Color fundus image — 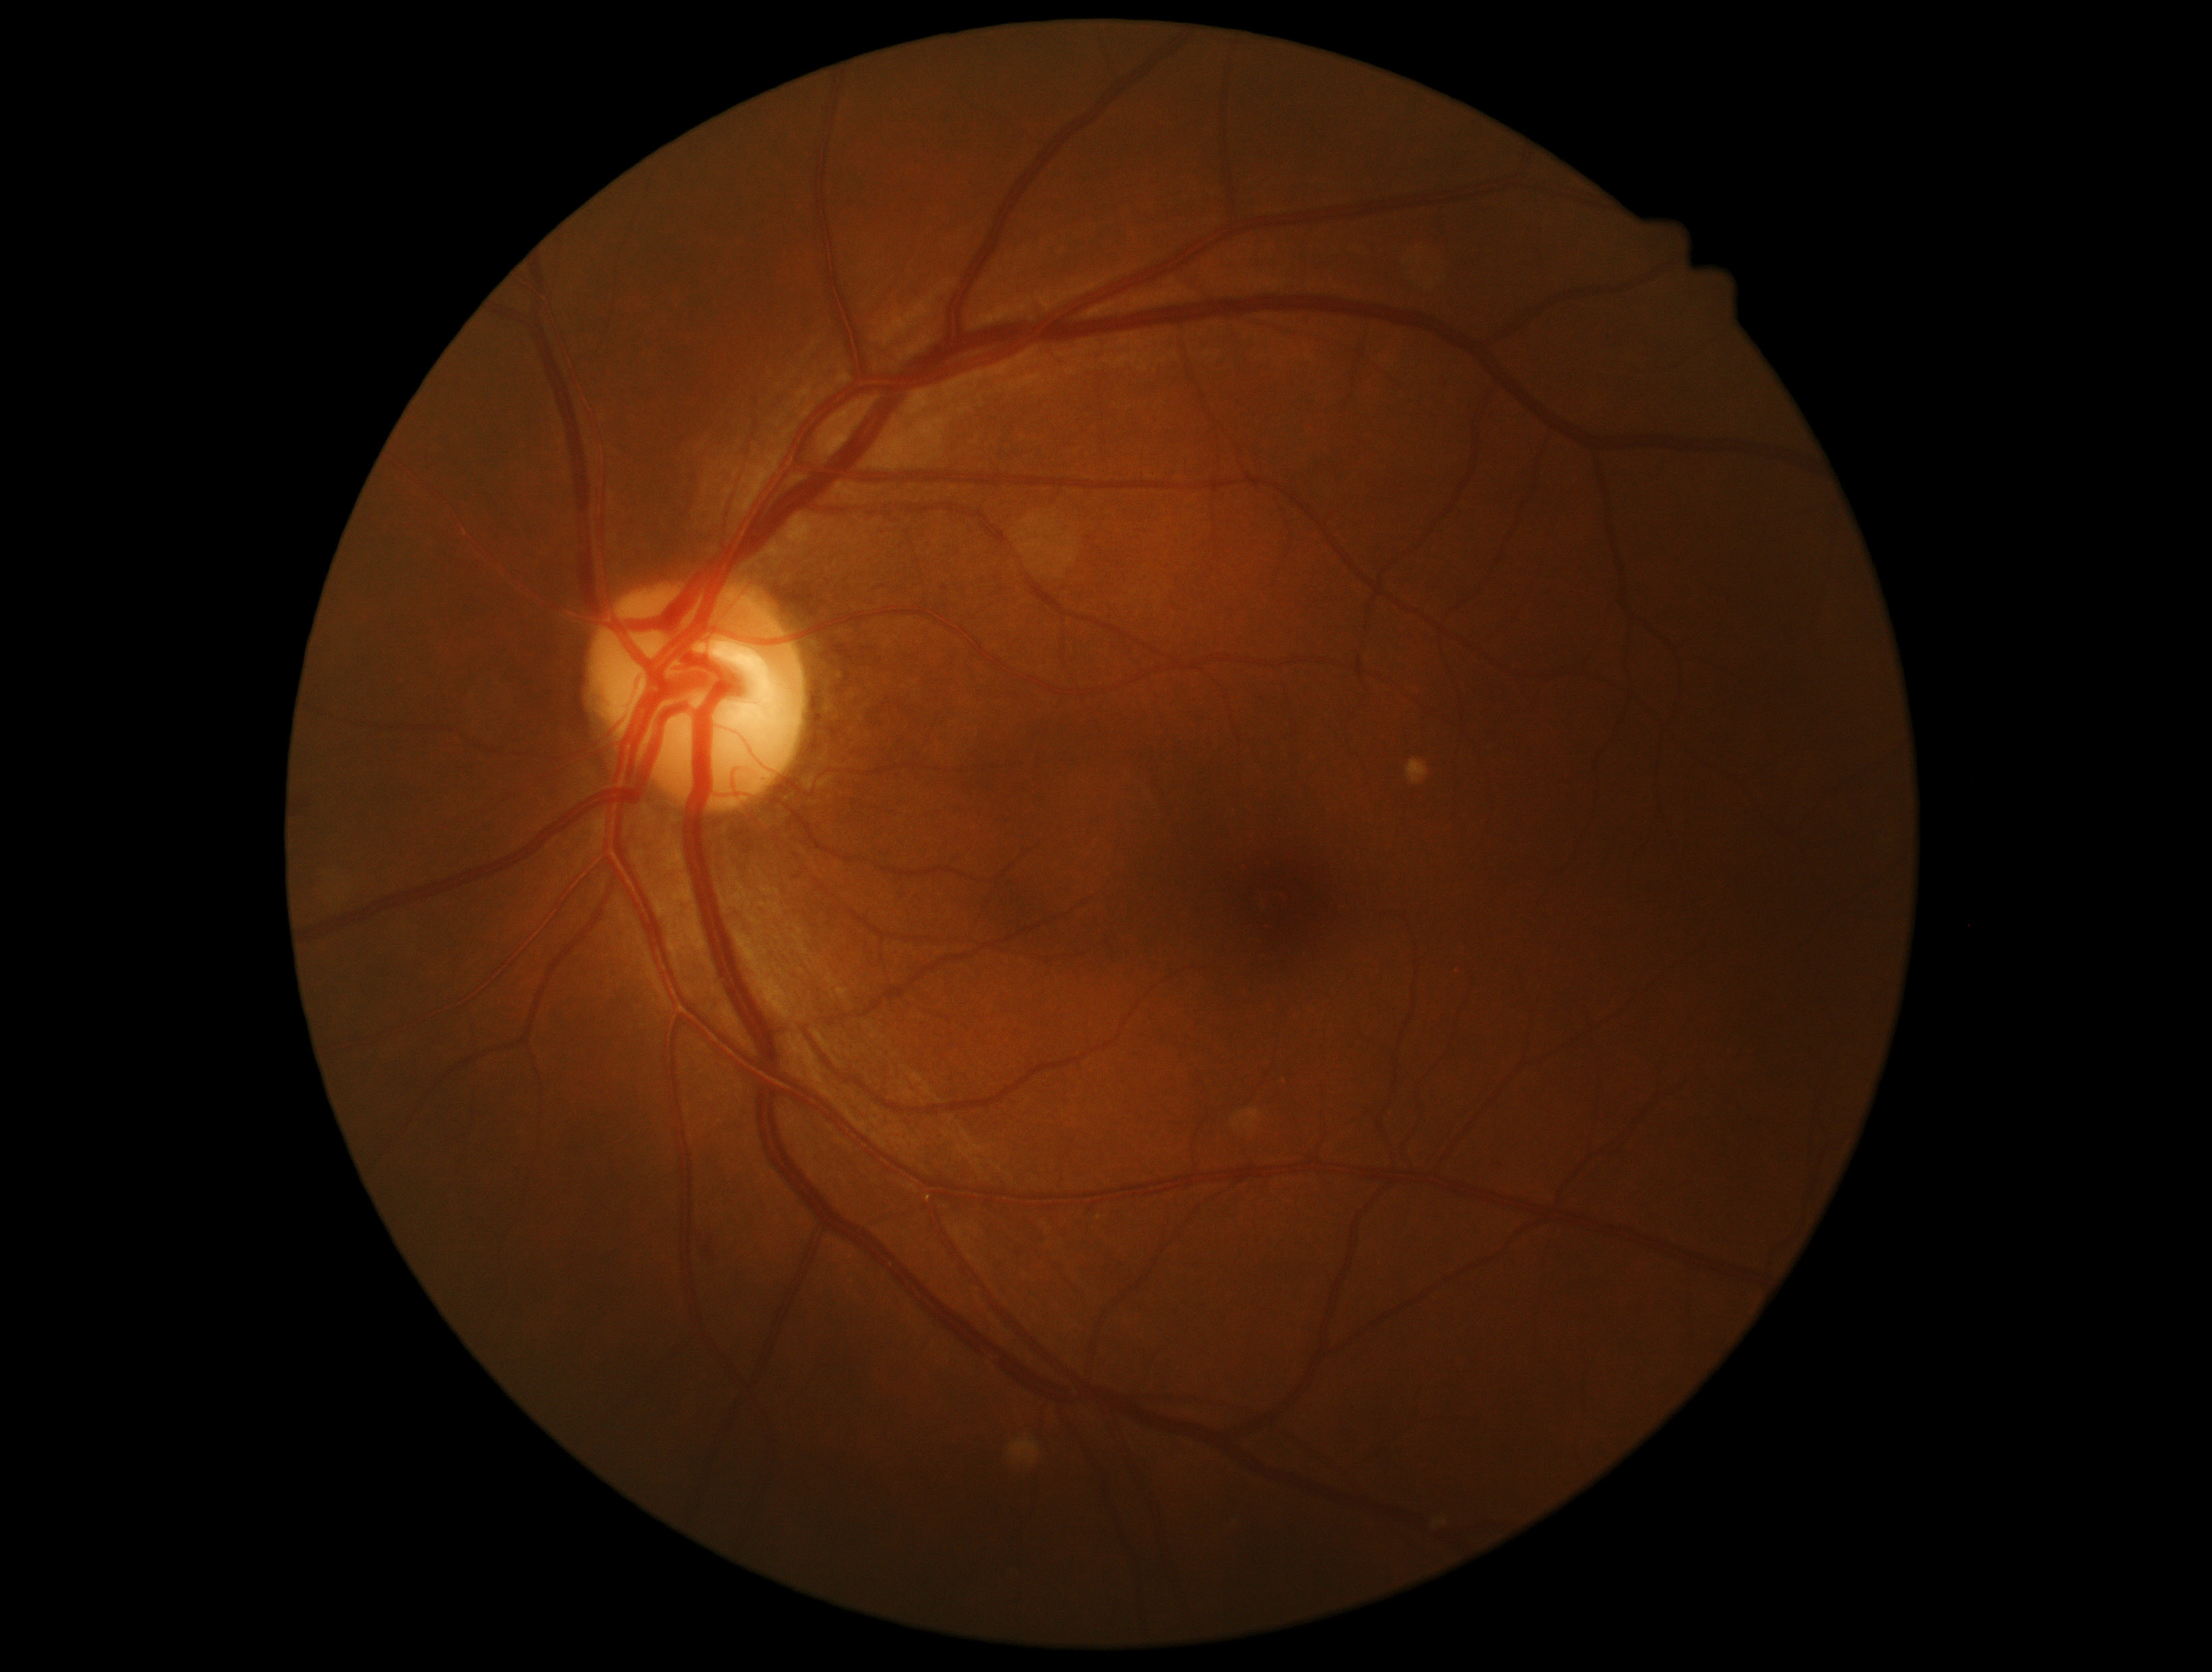 Diabetic retinopathy: grade 1 (mild NPDR).